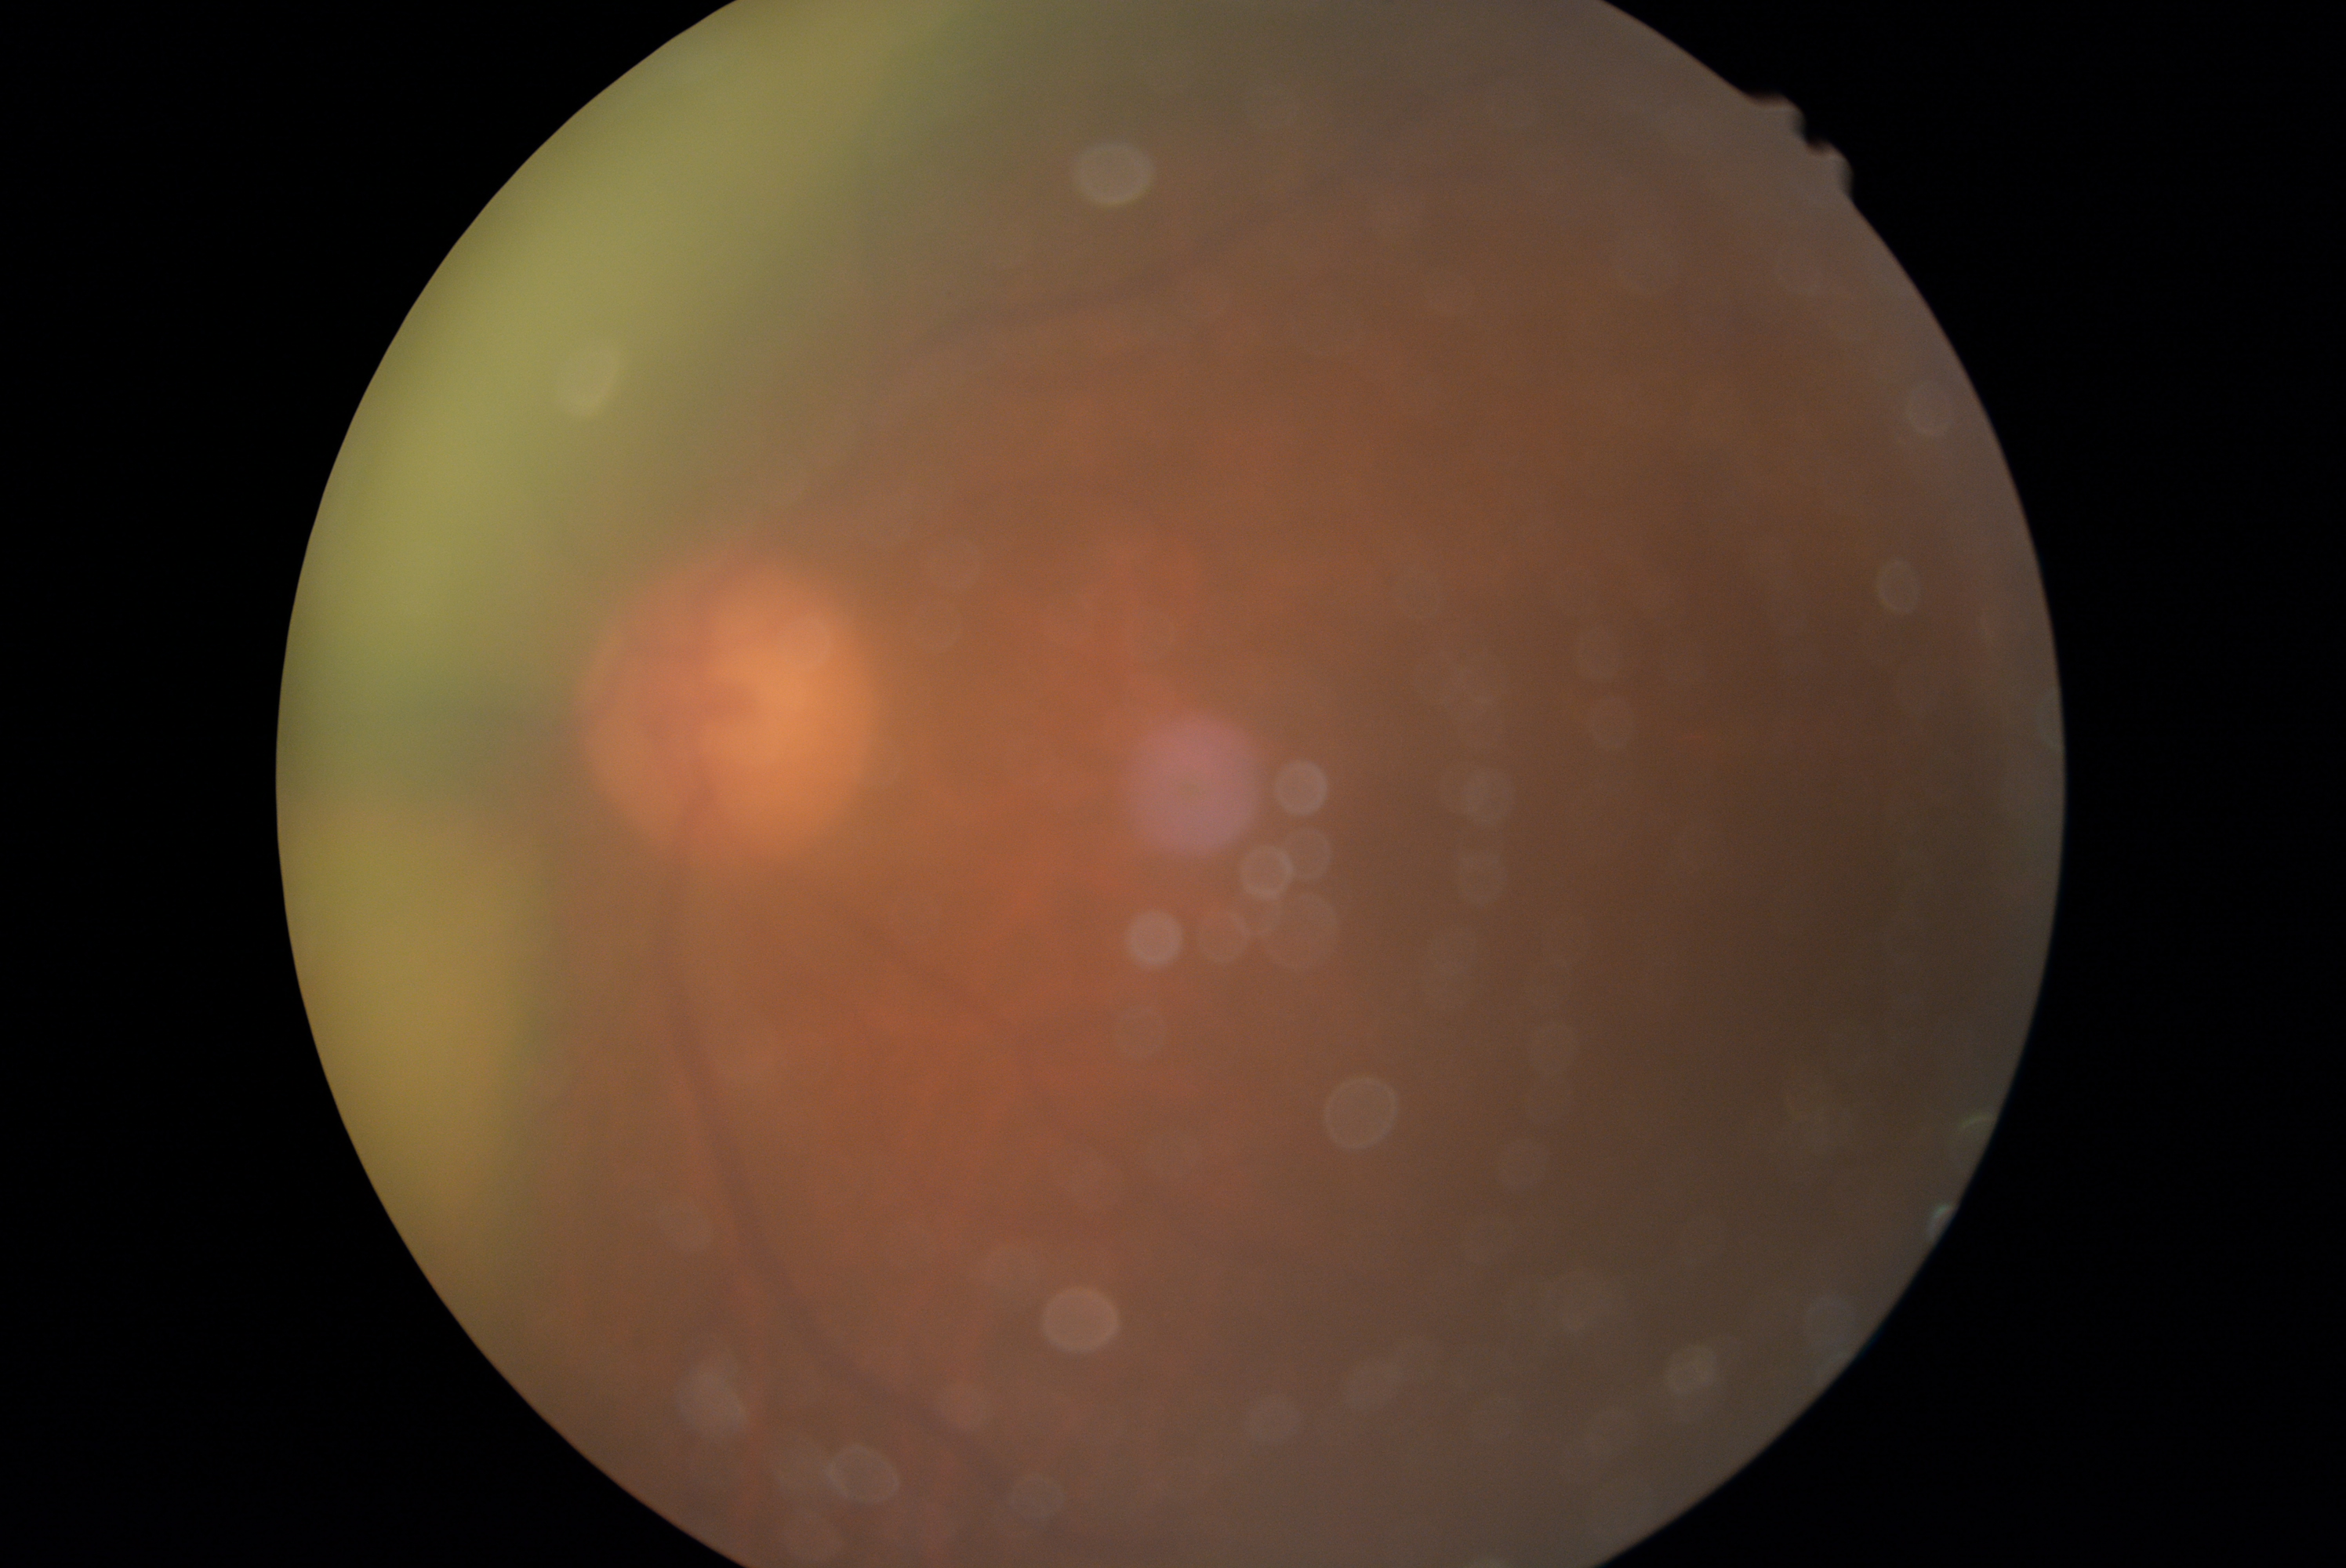
DR is ungradable due to poor image quality.